2352x1568 · 45-degree field of view · CFP: 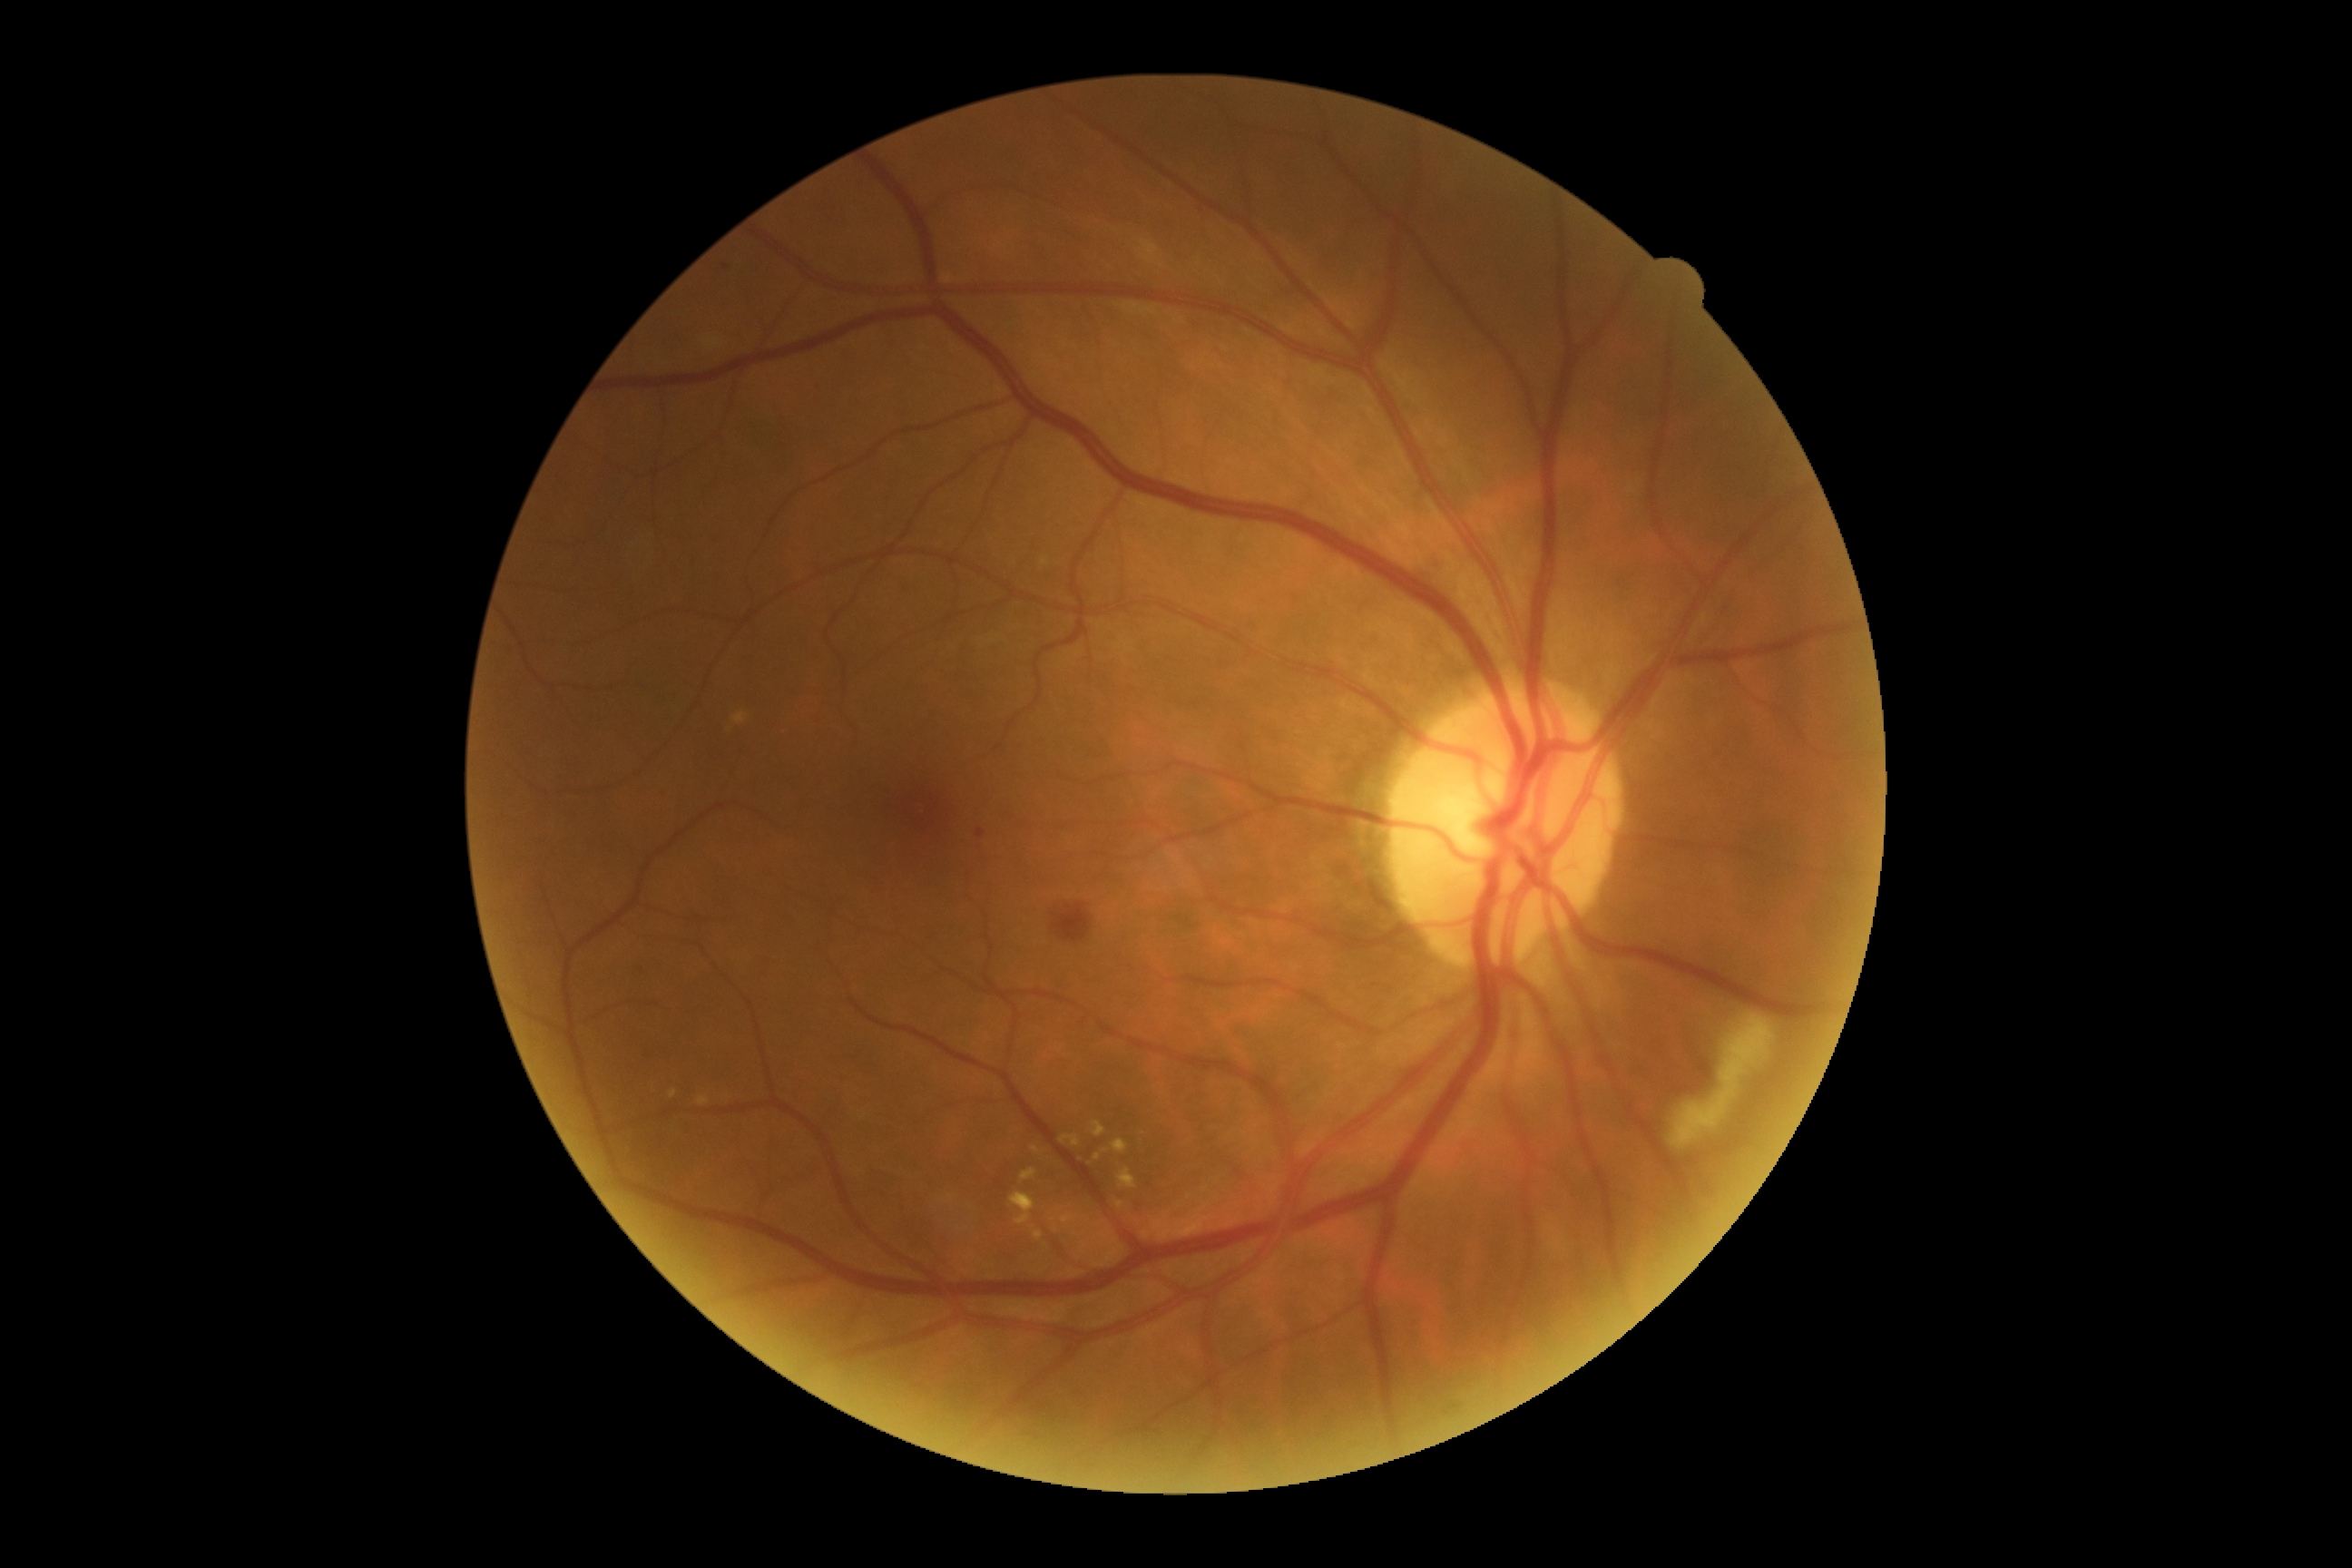

Diabetic retinopathy (DR) is moderate NPDR (grade 2).
Disease class: non-proliferative diabetic retinopathy.